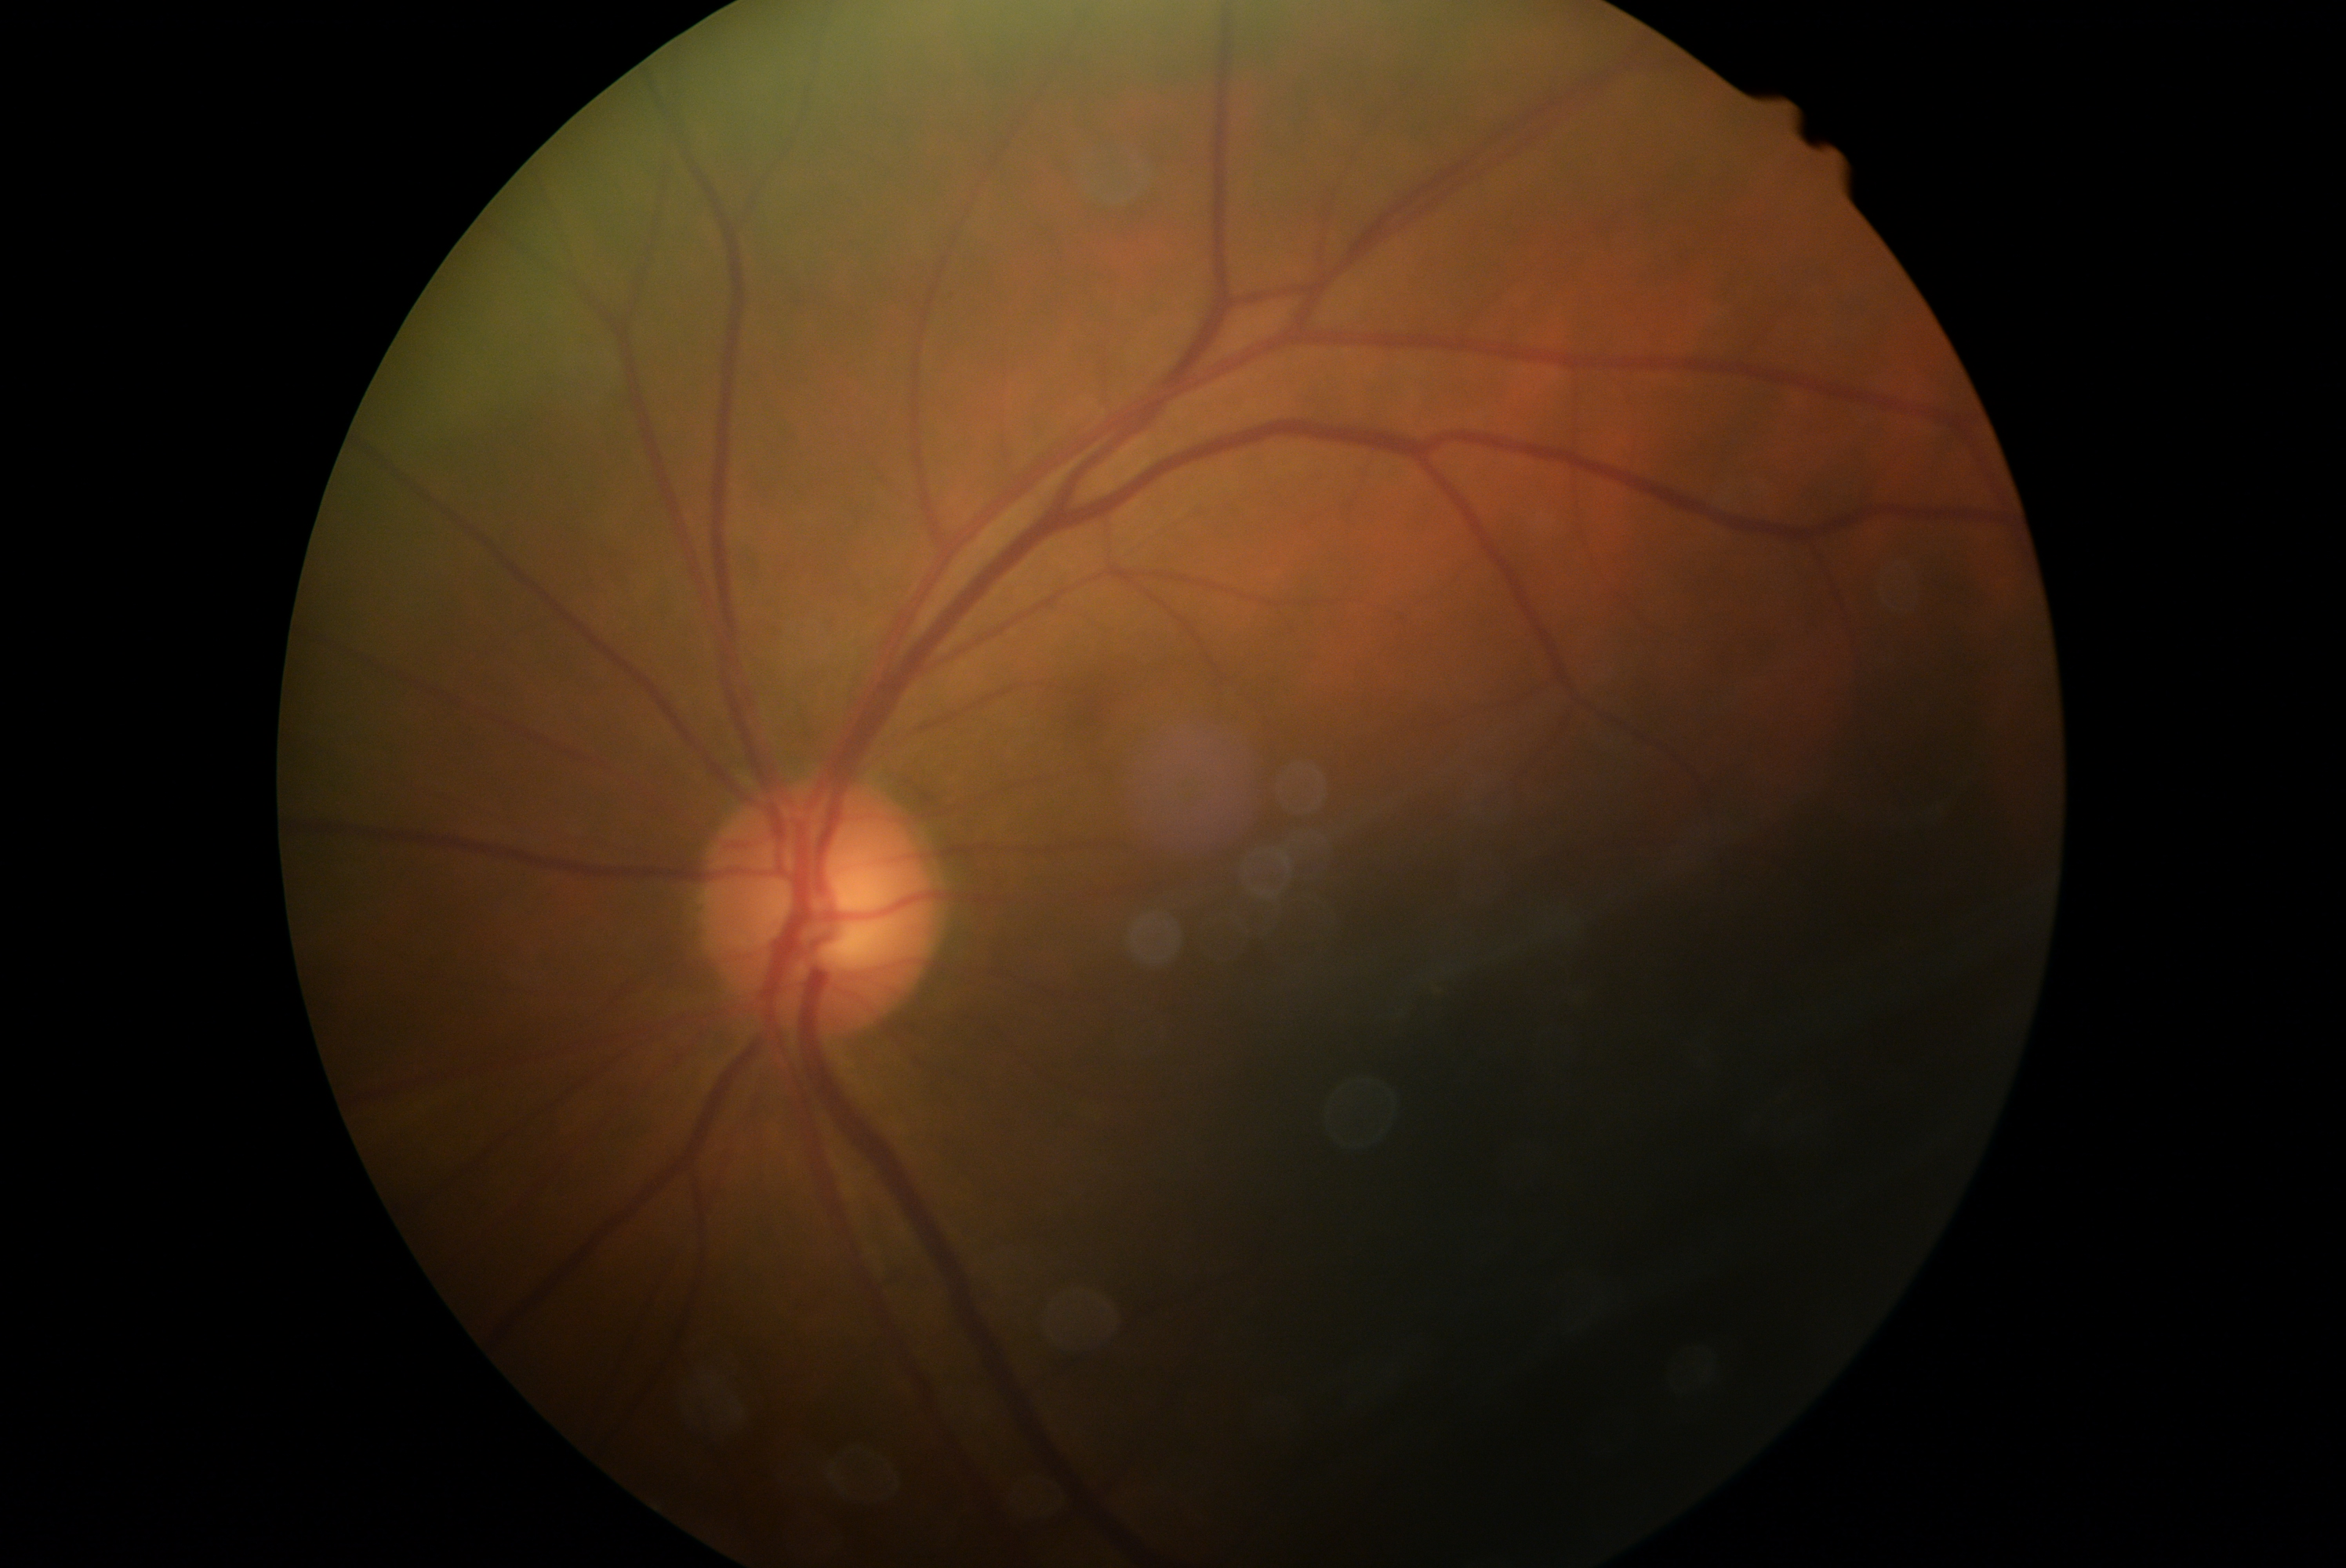
No apparent diabetic retinopathy. Diabetic retinopathy is grade 0.